Davis DR grading; 848x848 — 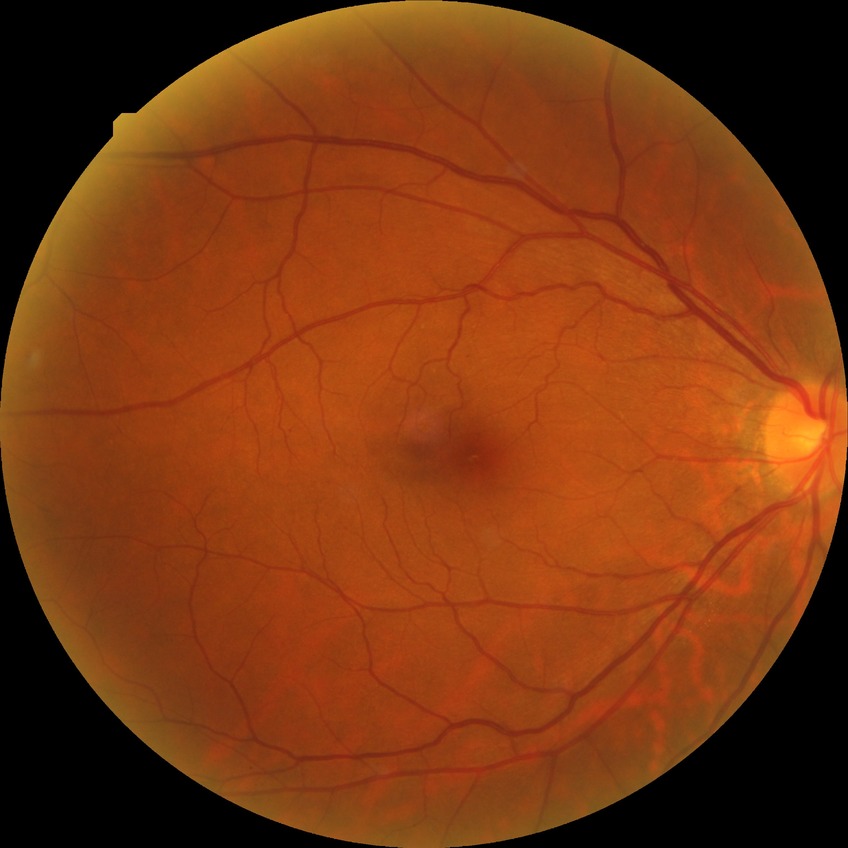

Disease class: non-proliferative diabetic retinopathy.
Diabetic retinopathy (DR) is SDR (simple diabetic retinopathy).